Acquired with a NIDEK AFC-230; 45° FOV — 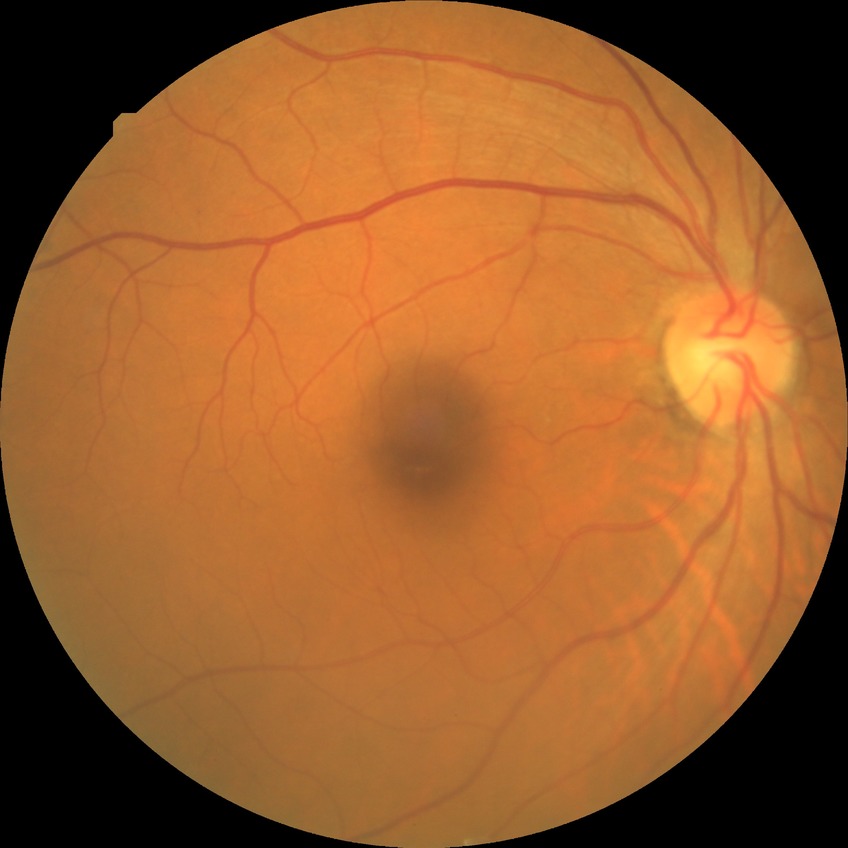
Diabetic retinopathy (DR): no diabetic retinopathy (NDR).